Acquired on the Phoenix ICON; pediatric wide-field fundus photograph — 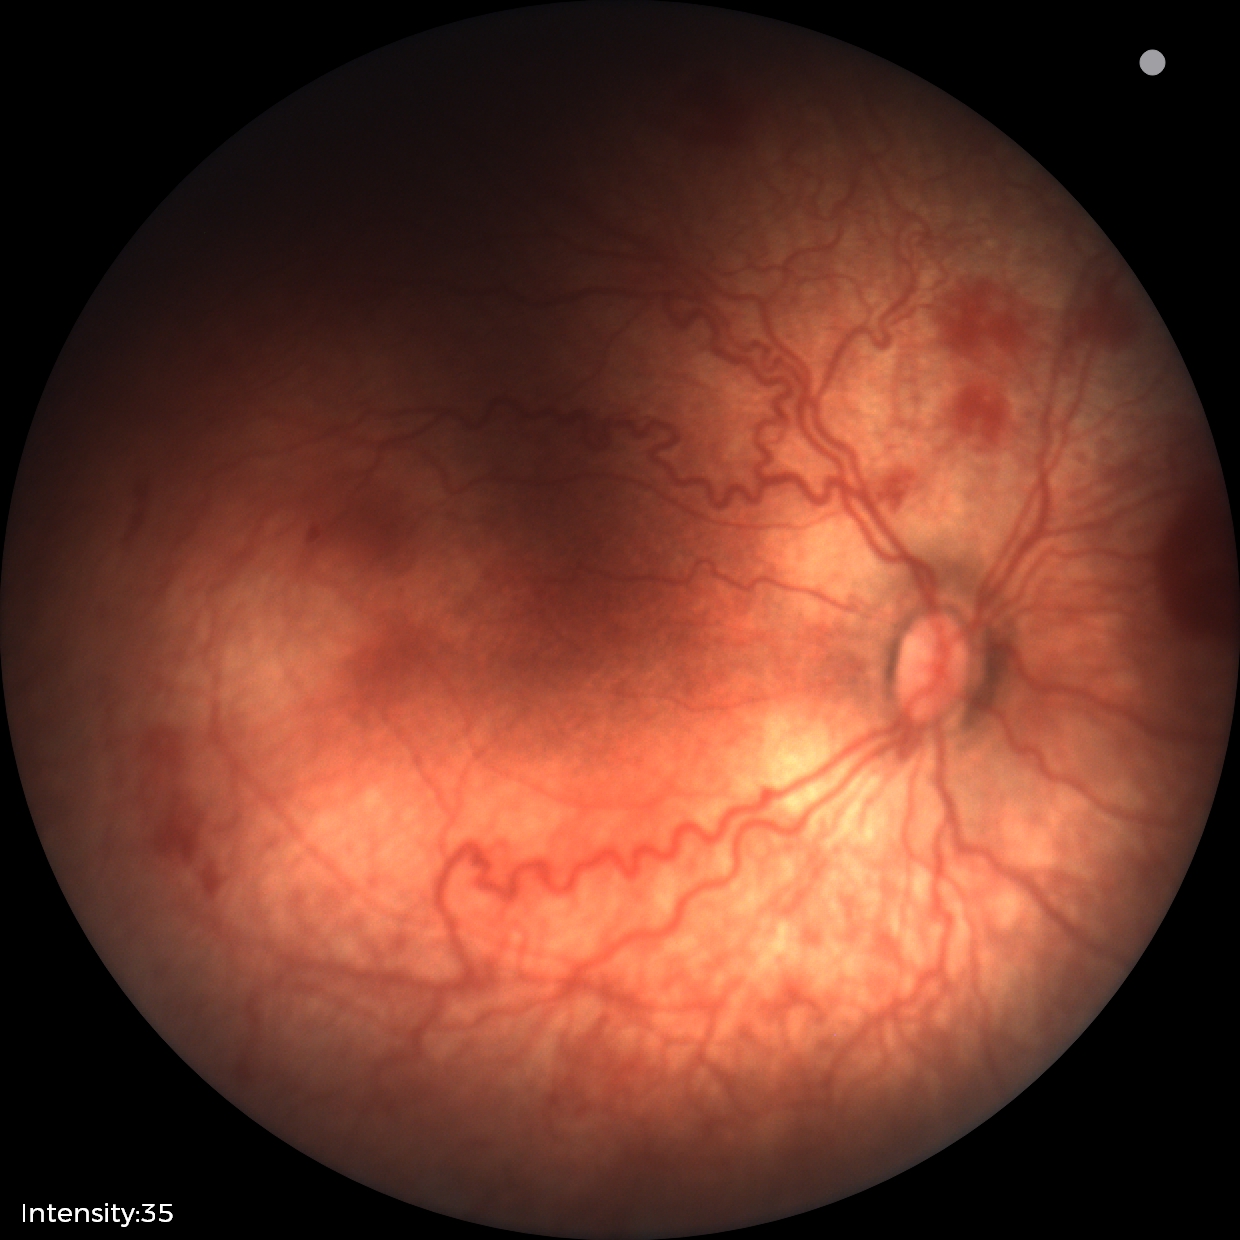 Q: Is plus disease present?
A: plus disease
Q: What is the screening diagnosis?
A: retinopathy of prematurity stage 2